Wide-field fundus image from infant ROP screening; 130° field of view (Natus RetCam Envision): 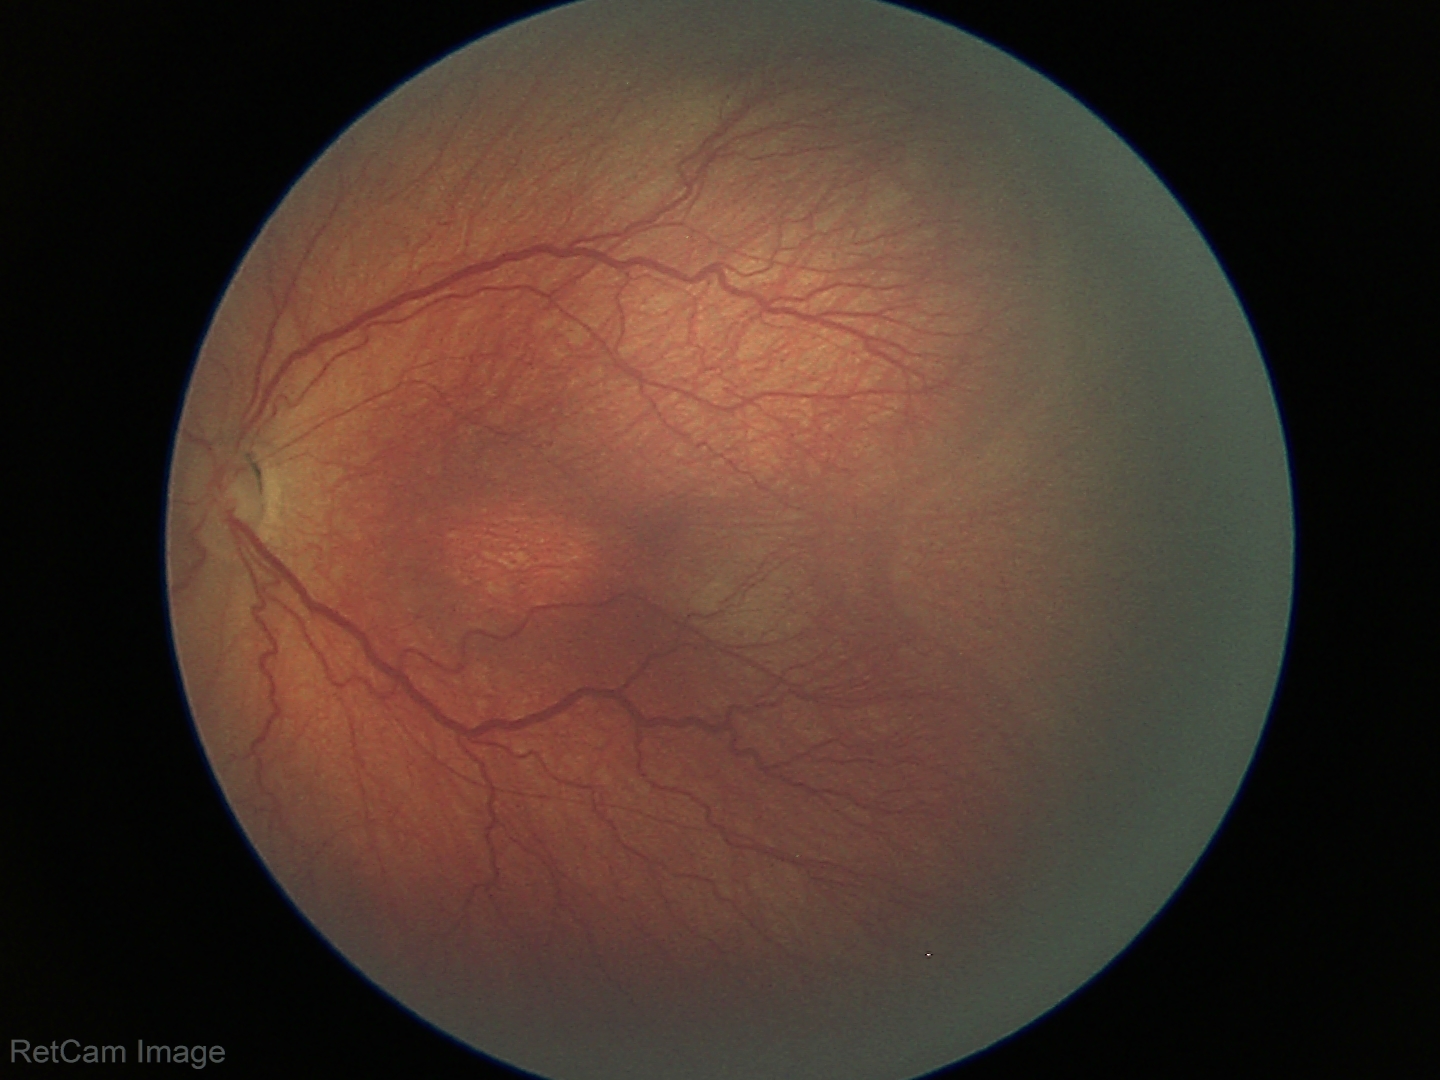
Plus disease absent.
Screening examination consistent with ROP stage 3.